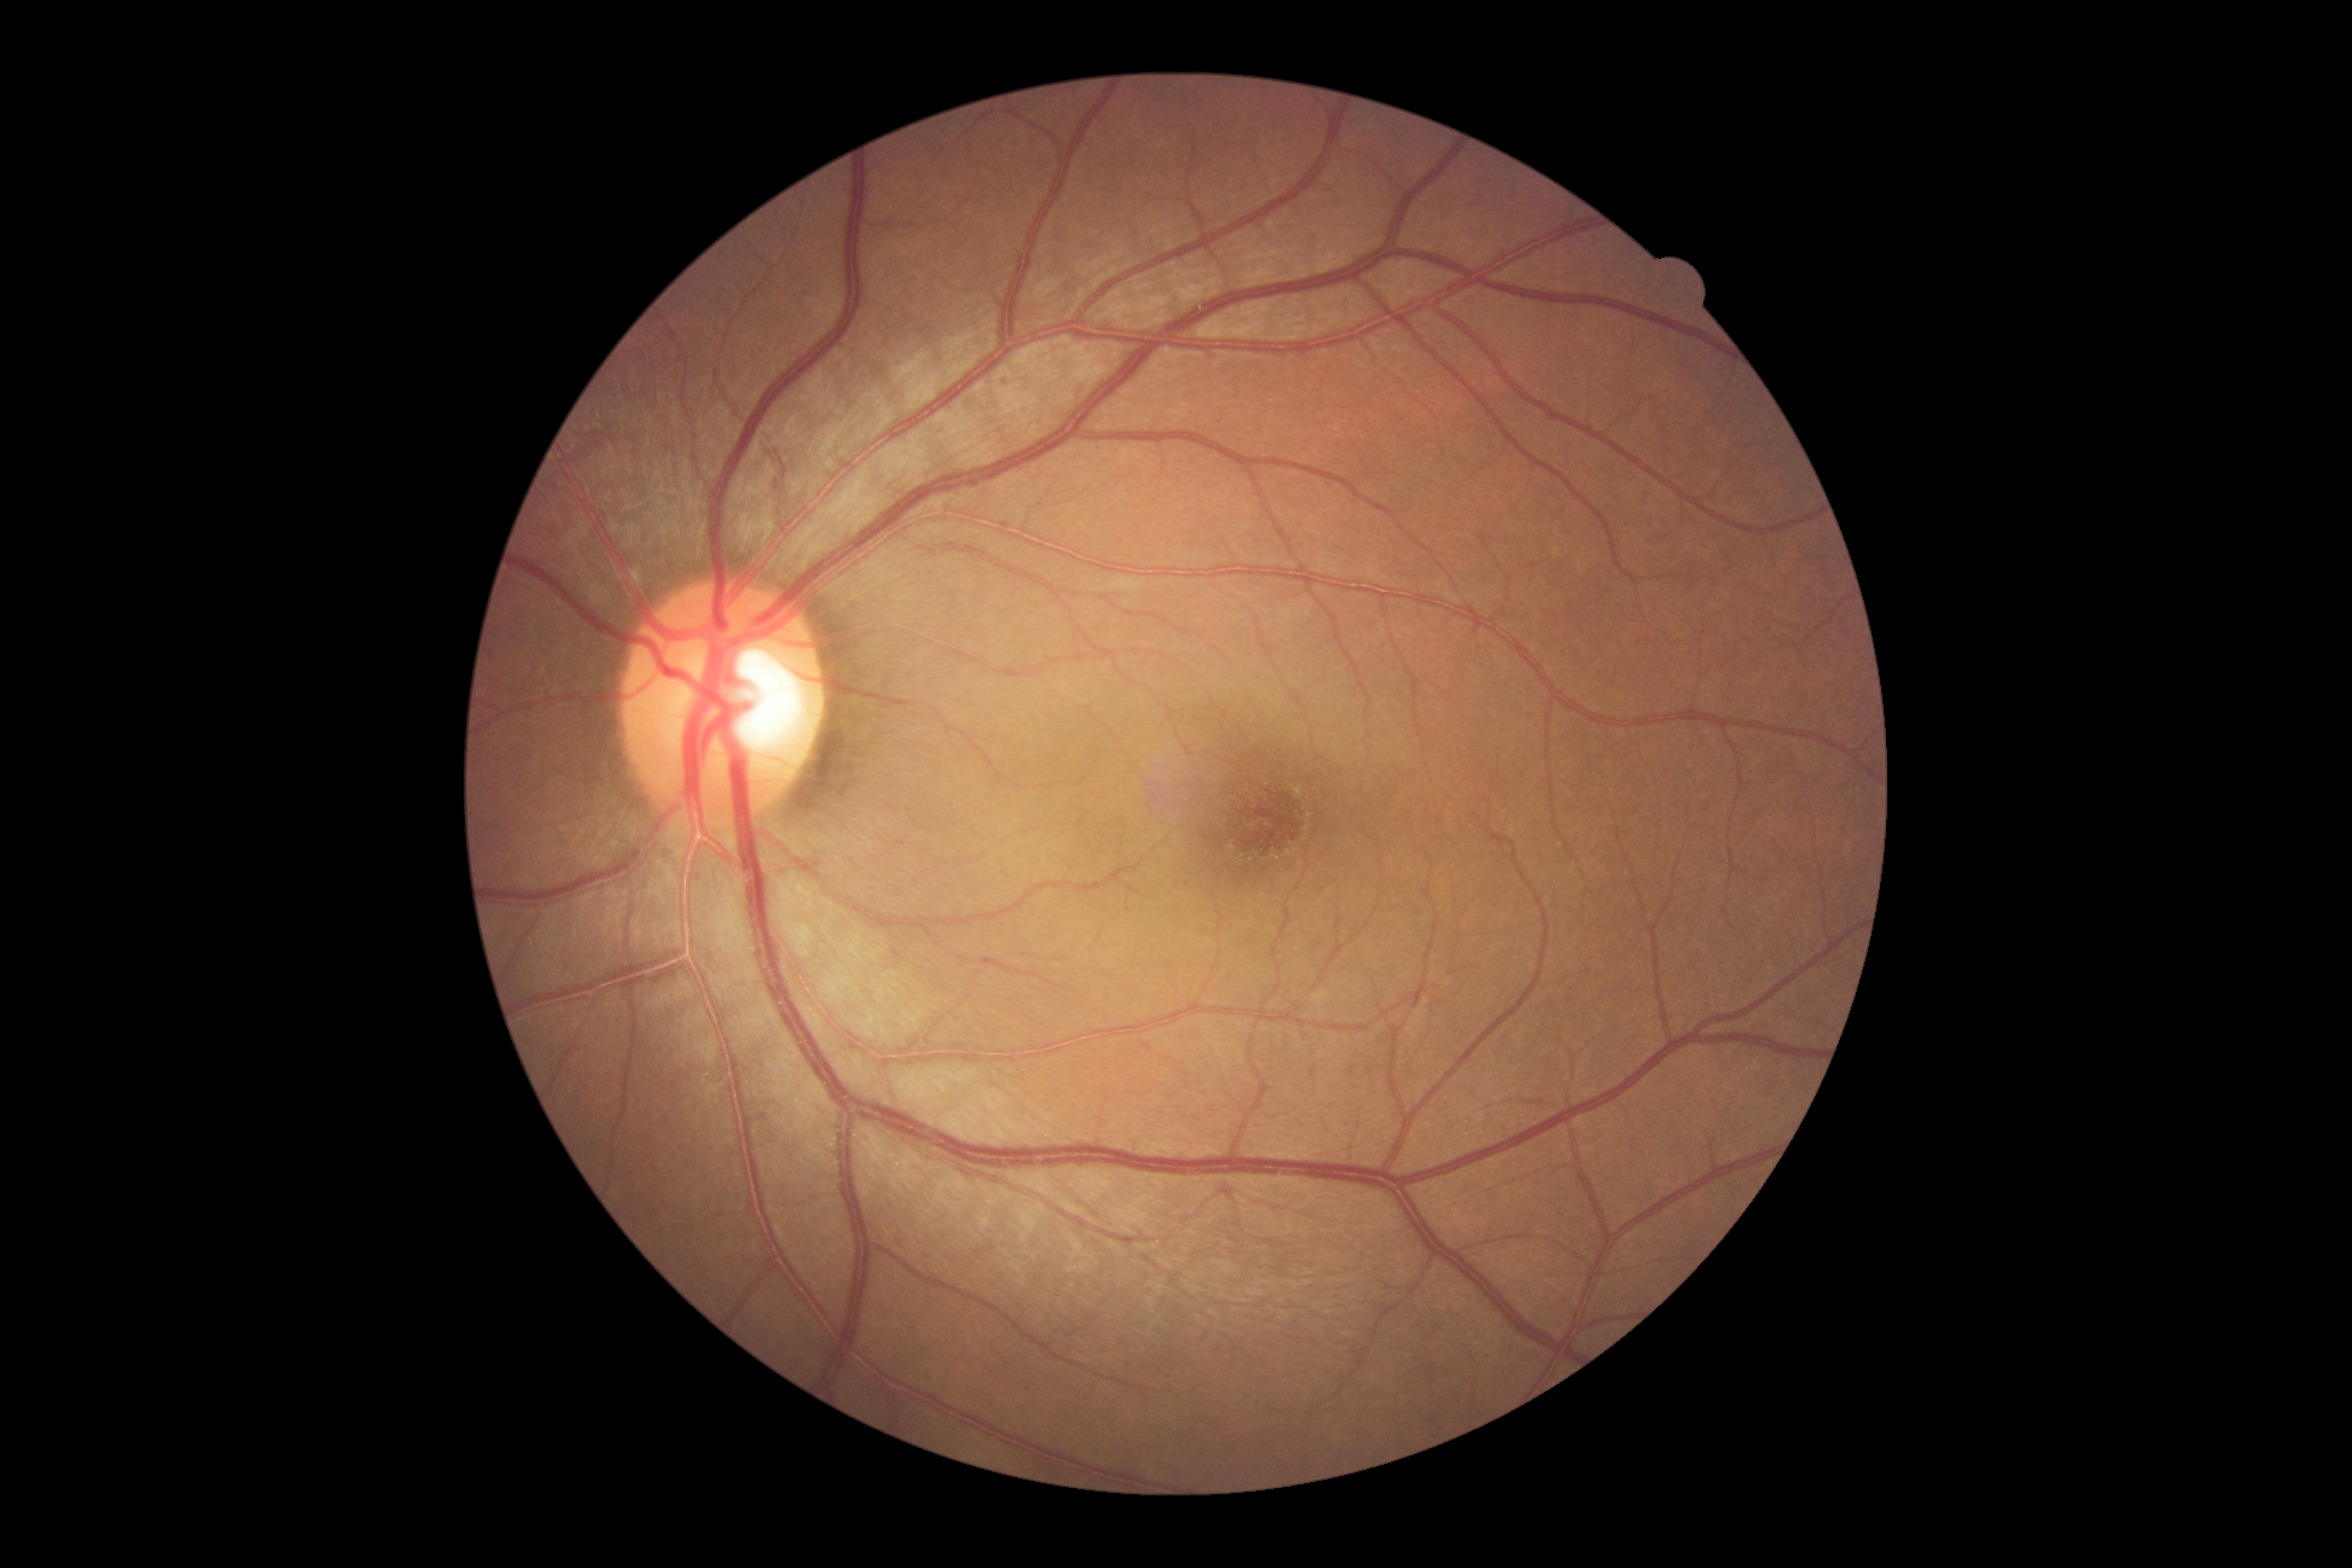

DR grade: 0/4.